Wide-field fundus photograph from neonatal ROP screening; 100° field of view (Phoenix ICON)
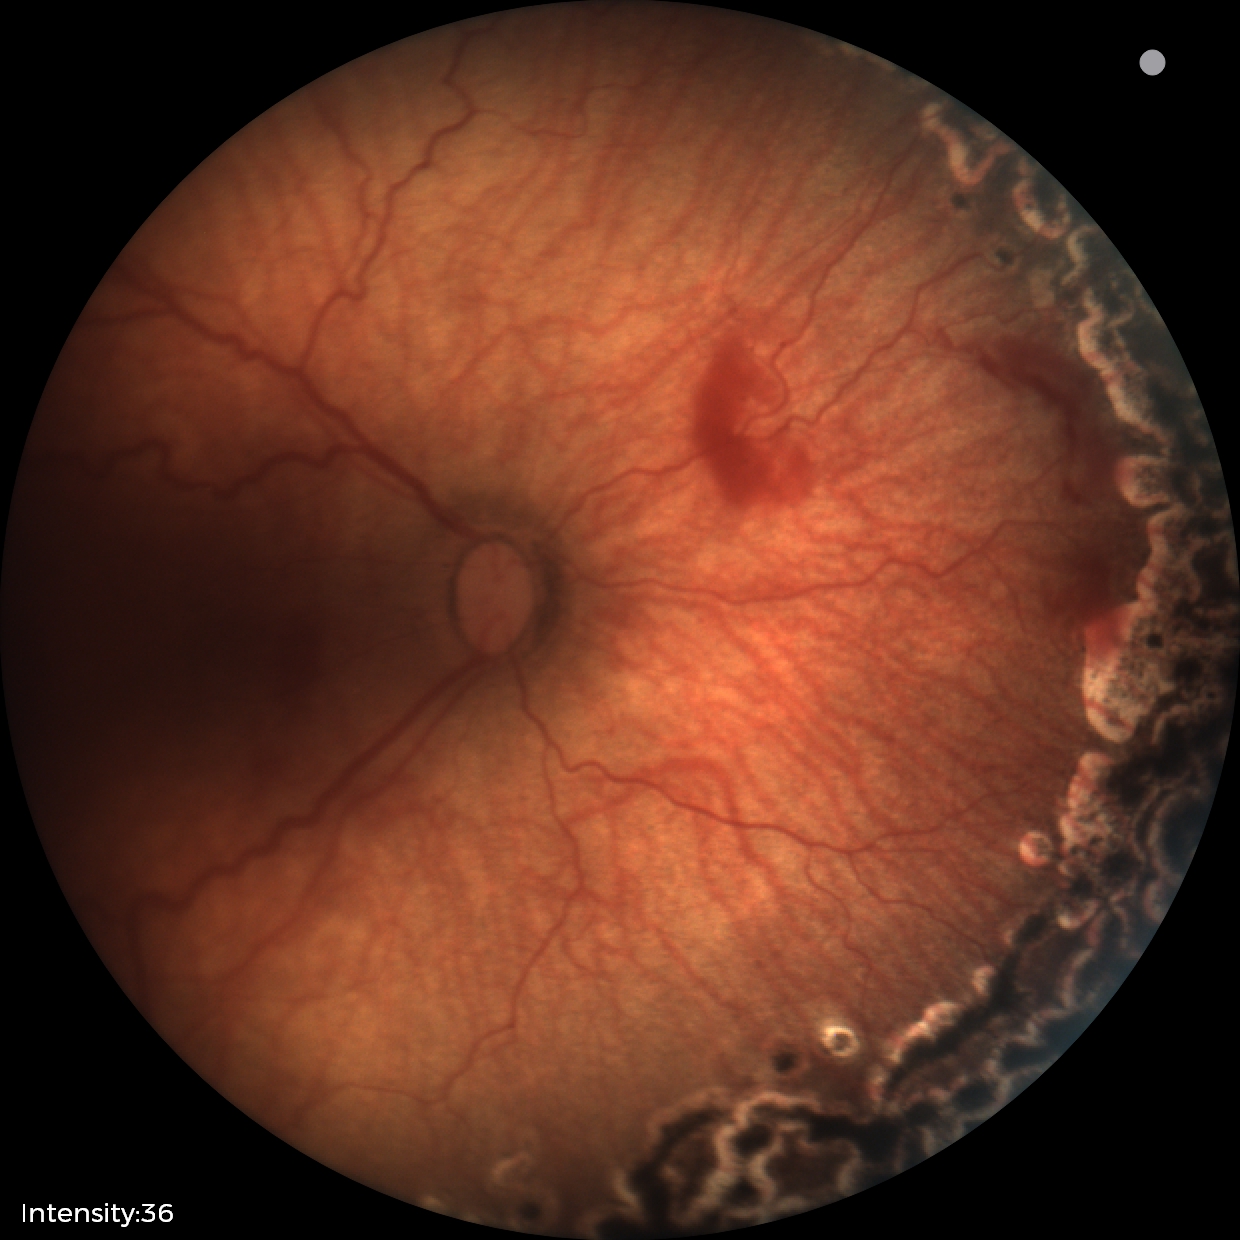 Screening series with status post ROP.